Clarity RetCam 3, 130° FOV · 640 x 480 pixels · infant wide-field fundus photograph: 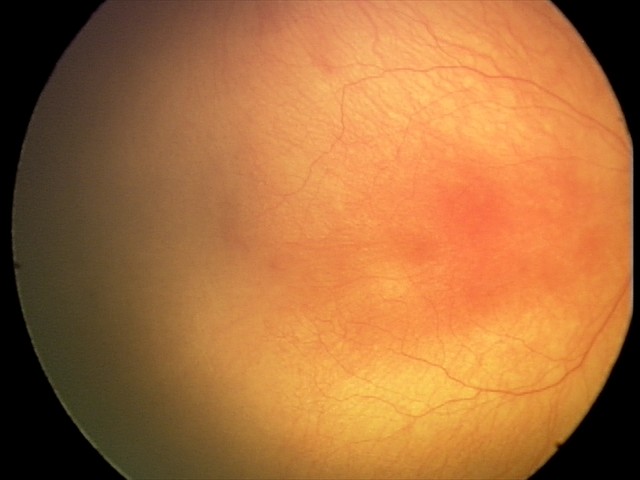
Q: What was the screening finding?
A: aggressive retinopathy of prematurity (A-ROP)